Tabletop color fundus camera image: 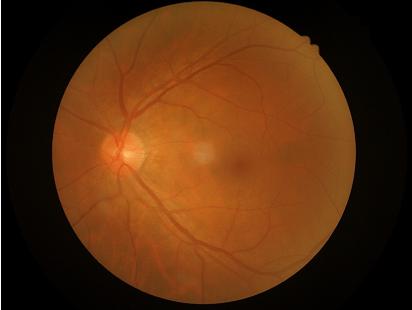

{"clarity": "clear with no noticeable blur", "contrast": "vessels and details readily distinguishable"}